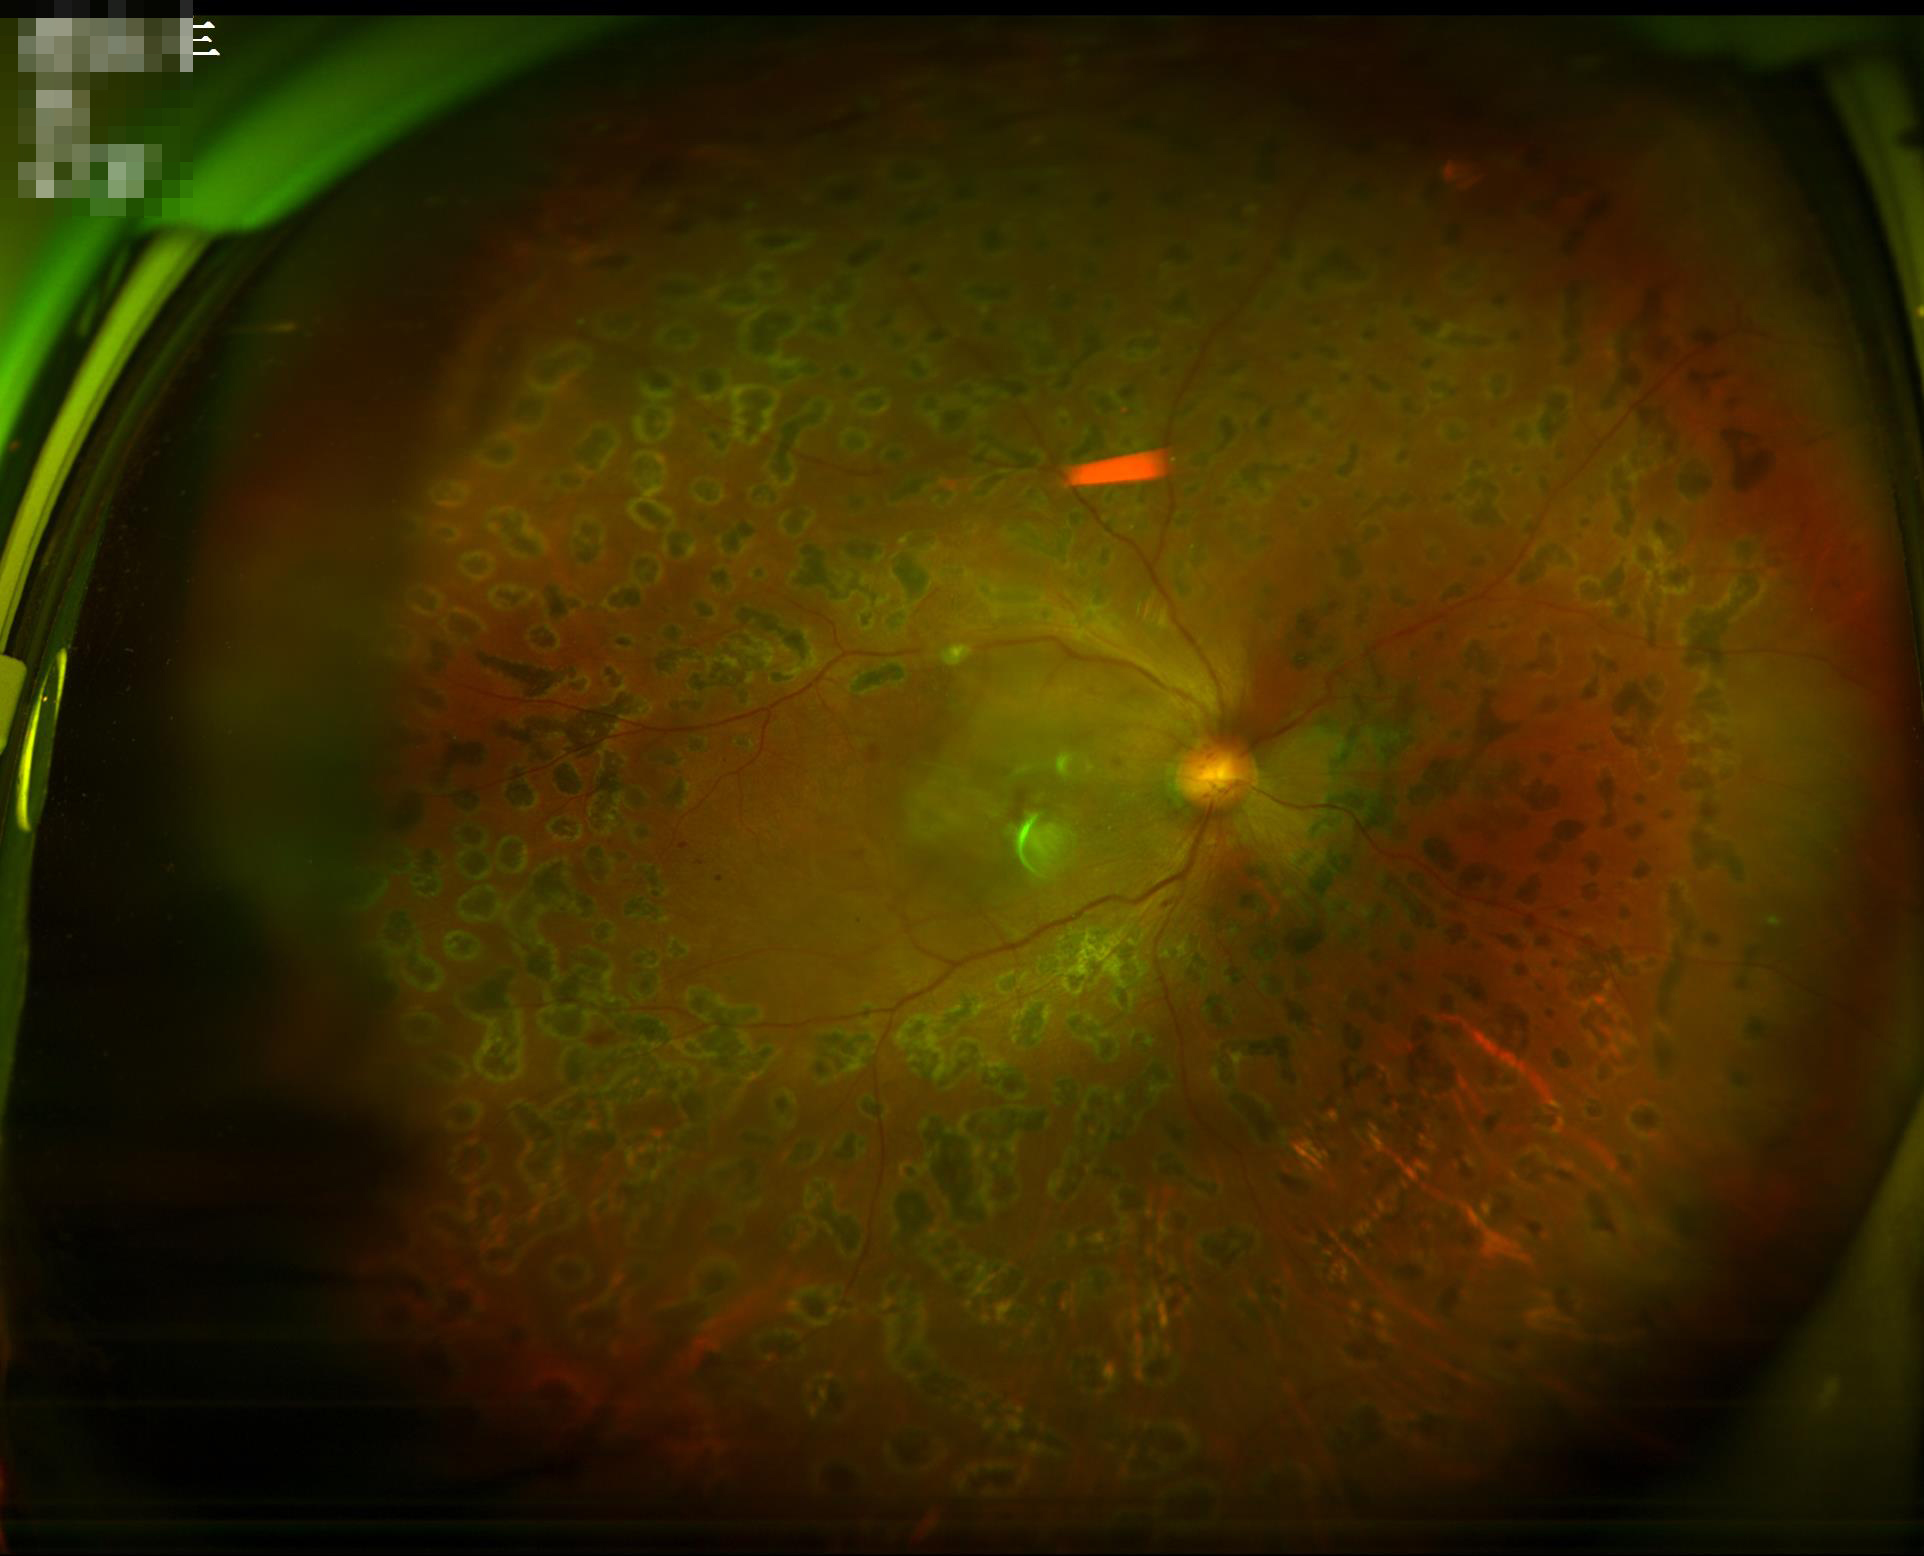 {
  "overall_quality": "satisfactory",
  "clarity": "in focus",
  "illumination": "uneven",
  "contrast": "adequate"
}